45° field of view; 2352x1568px:
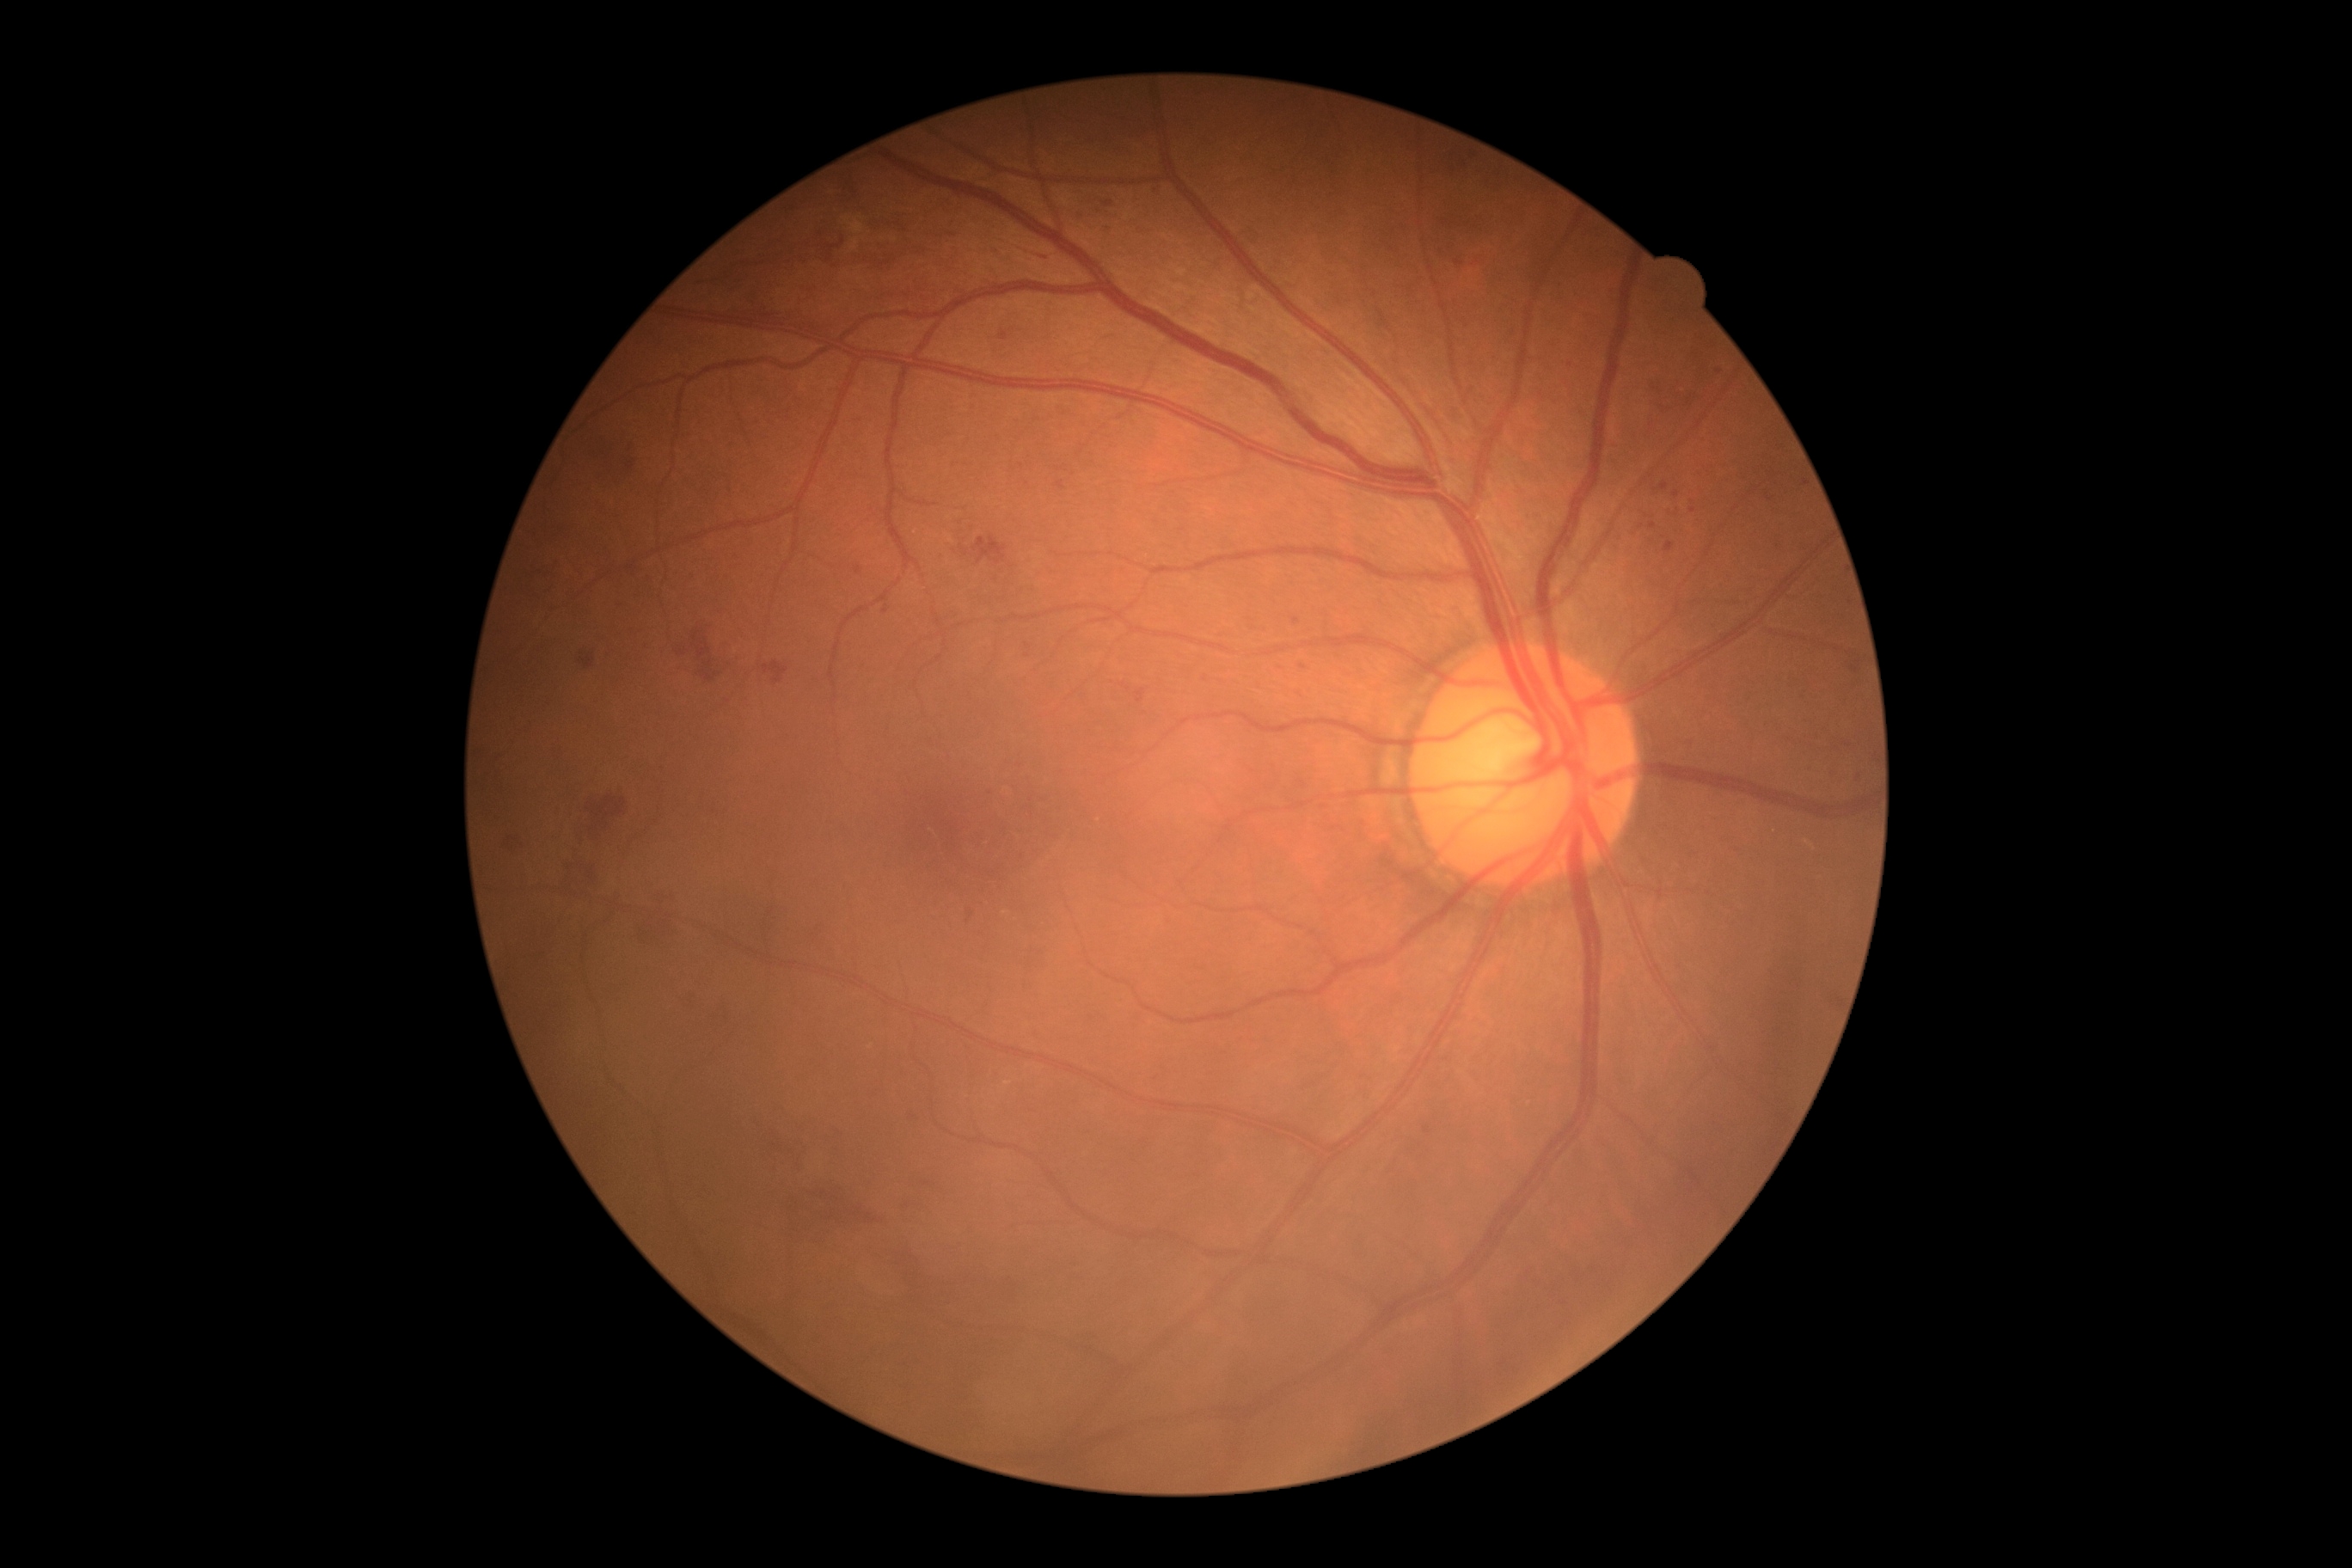
dr_grade: moderate non-proliferative diabetic retinopathy (grade 2)
dr_category: non-proliferative diabetic retinopathy